FOV: 45 degrees, 2048x1536:
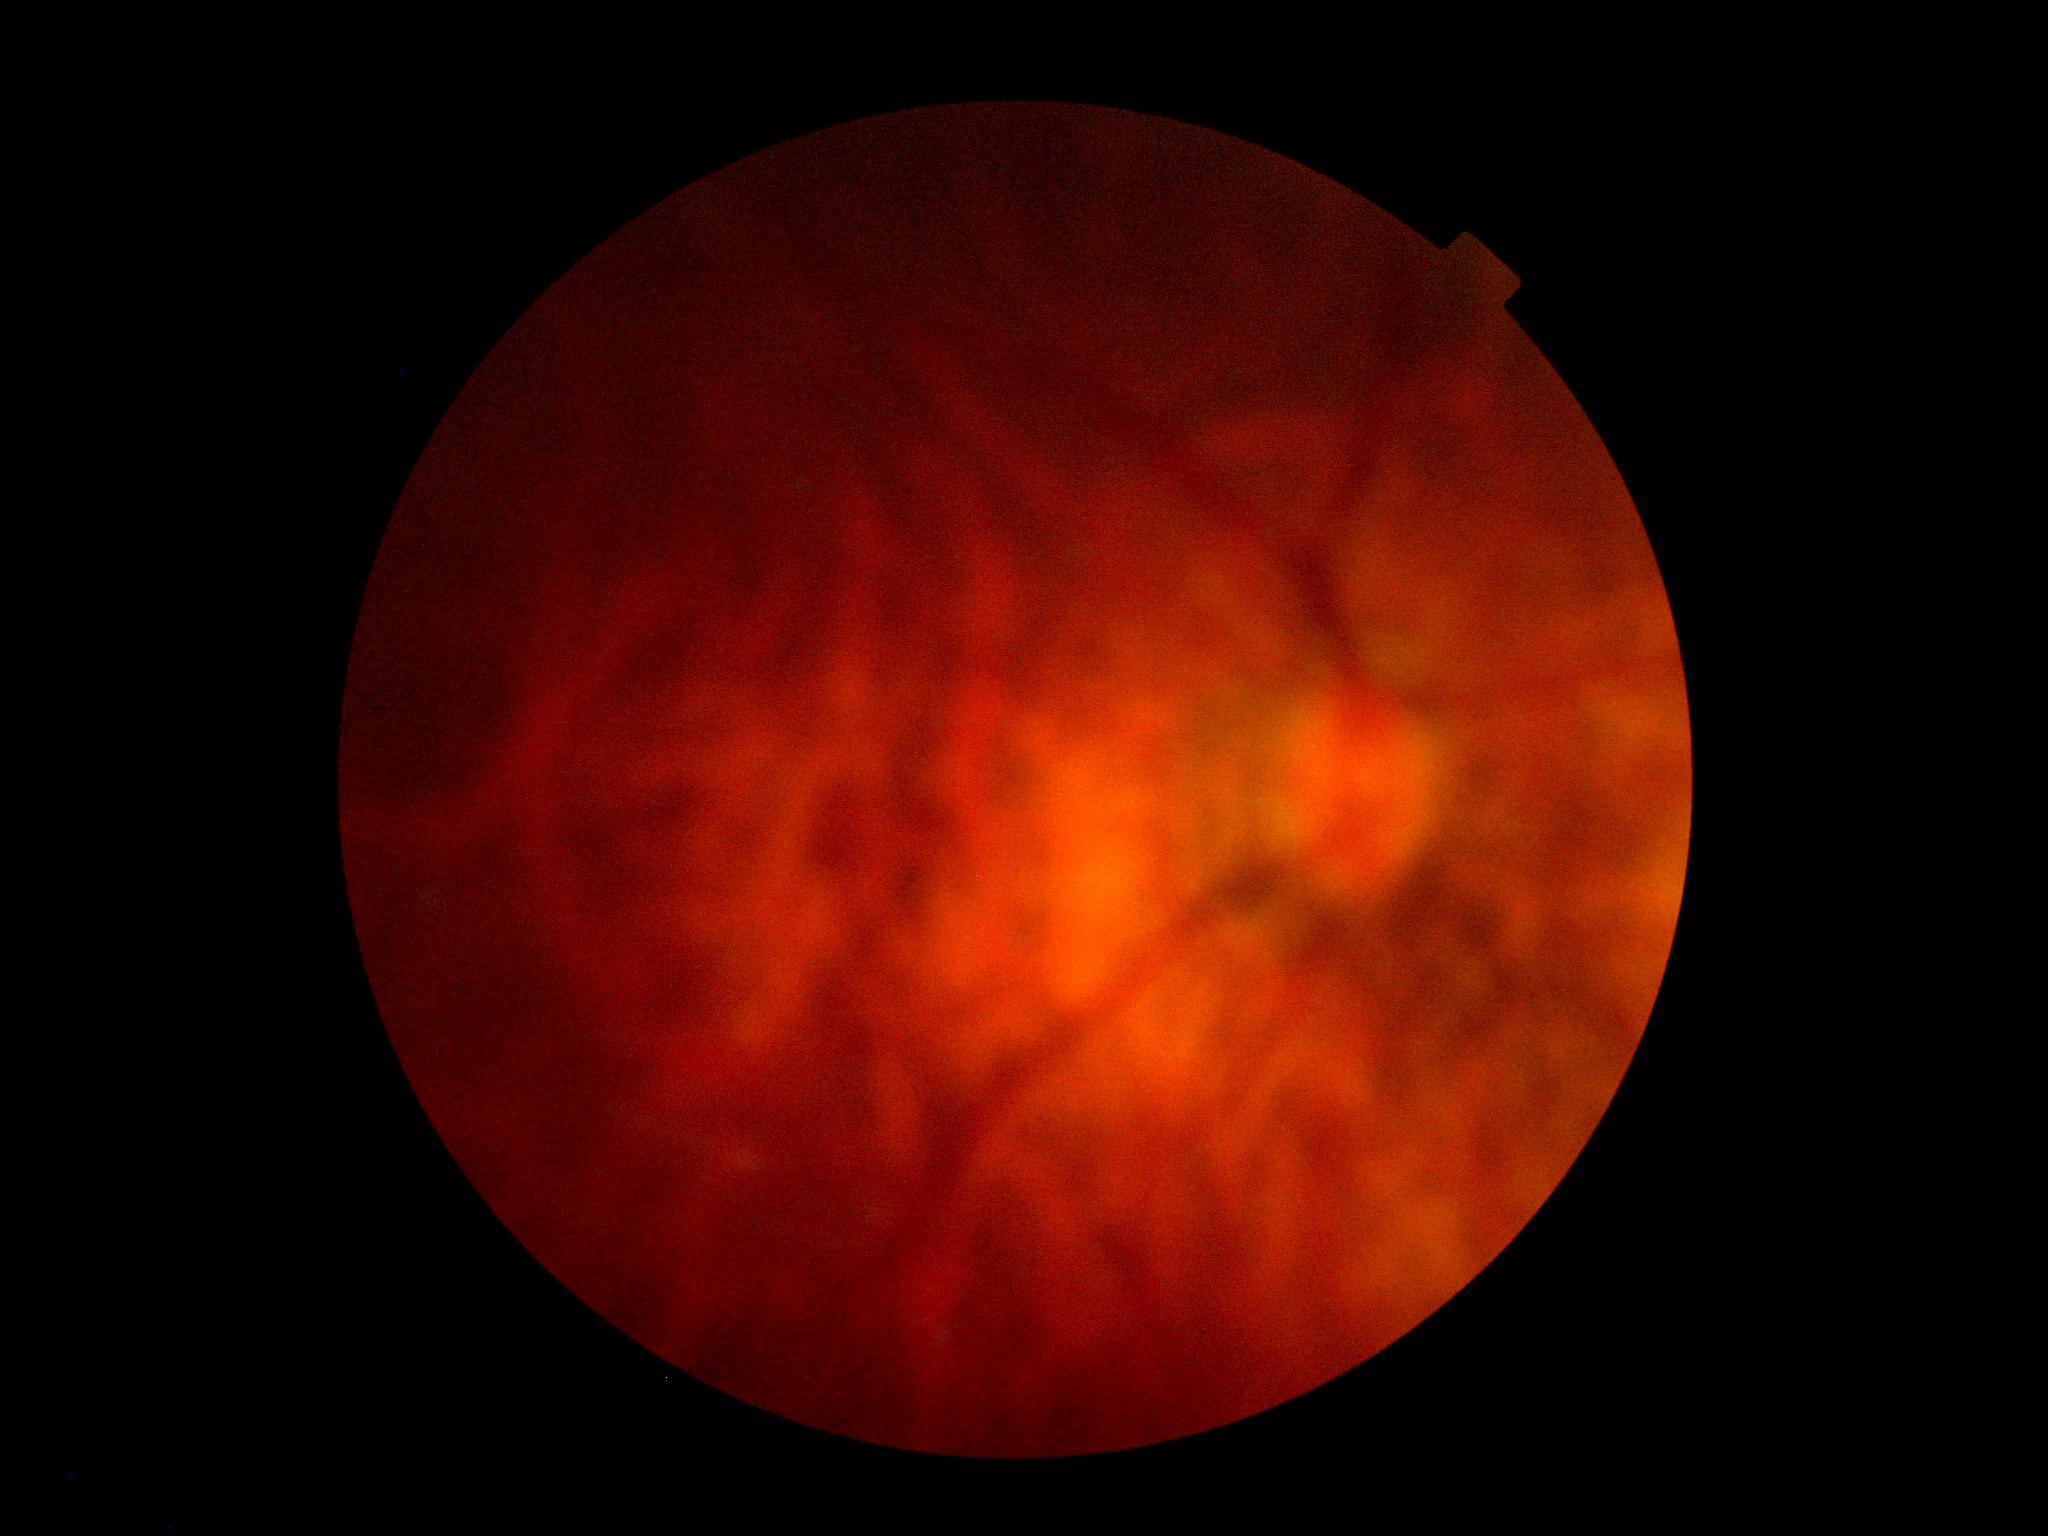
diabetic retinopathy (DR): ungradable.